Wide-field fundus photograph of an infant
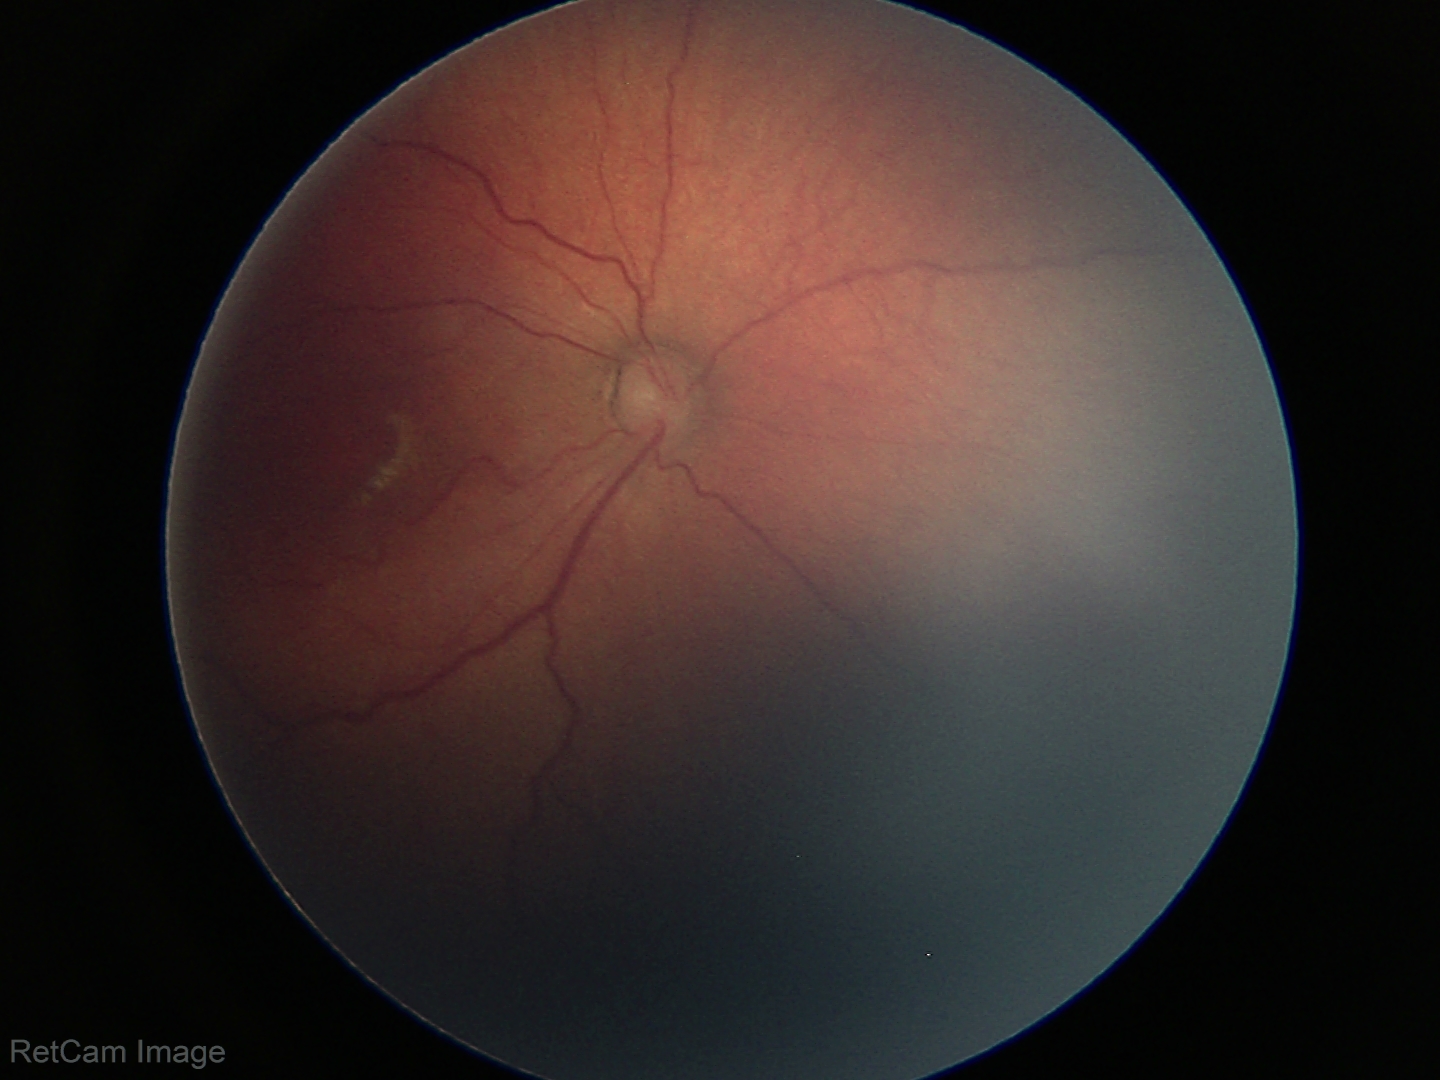
Diagnosis from this screening exam: ROP stage 3.